Fundus photo
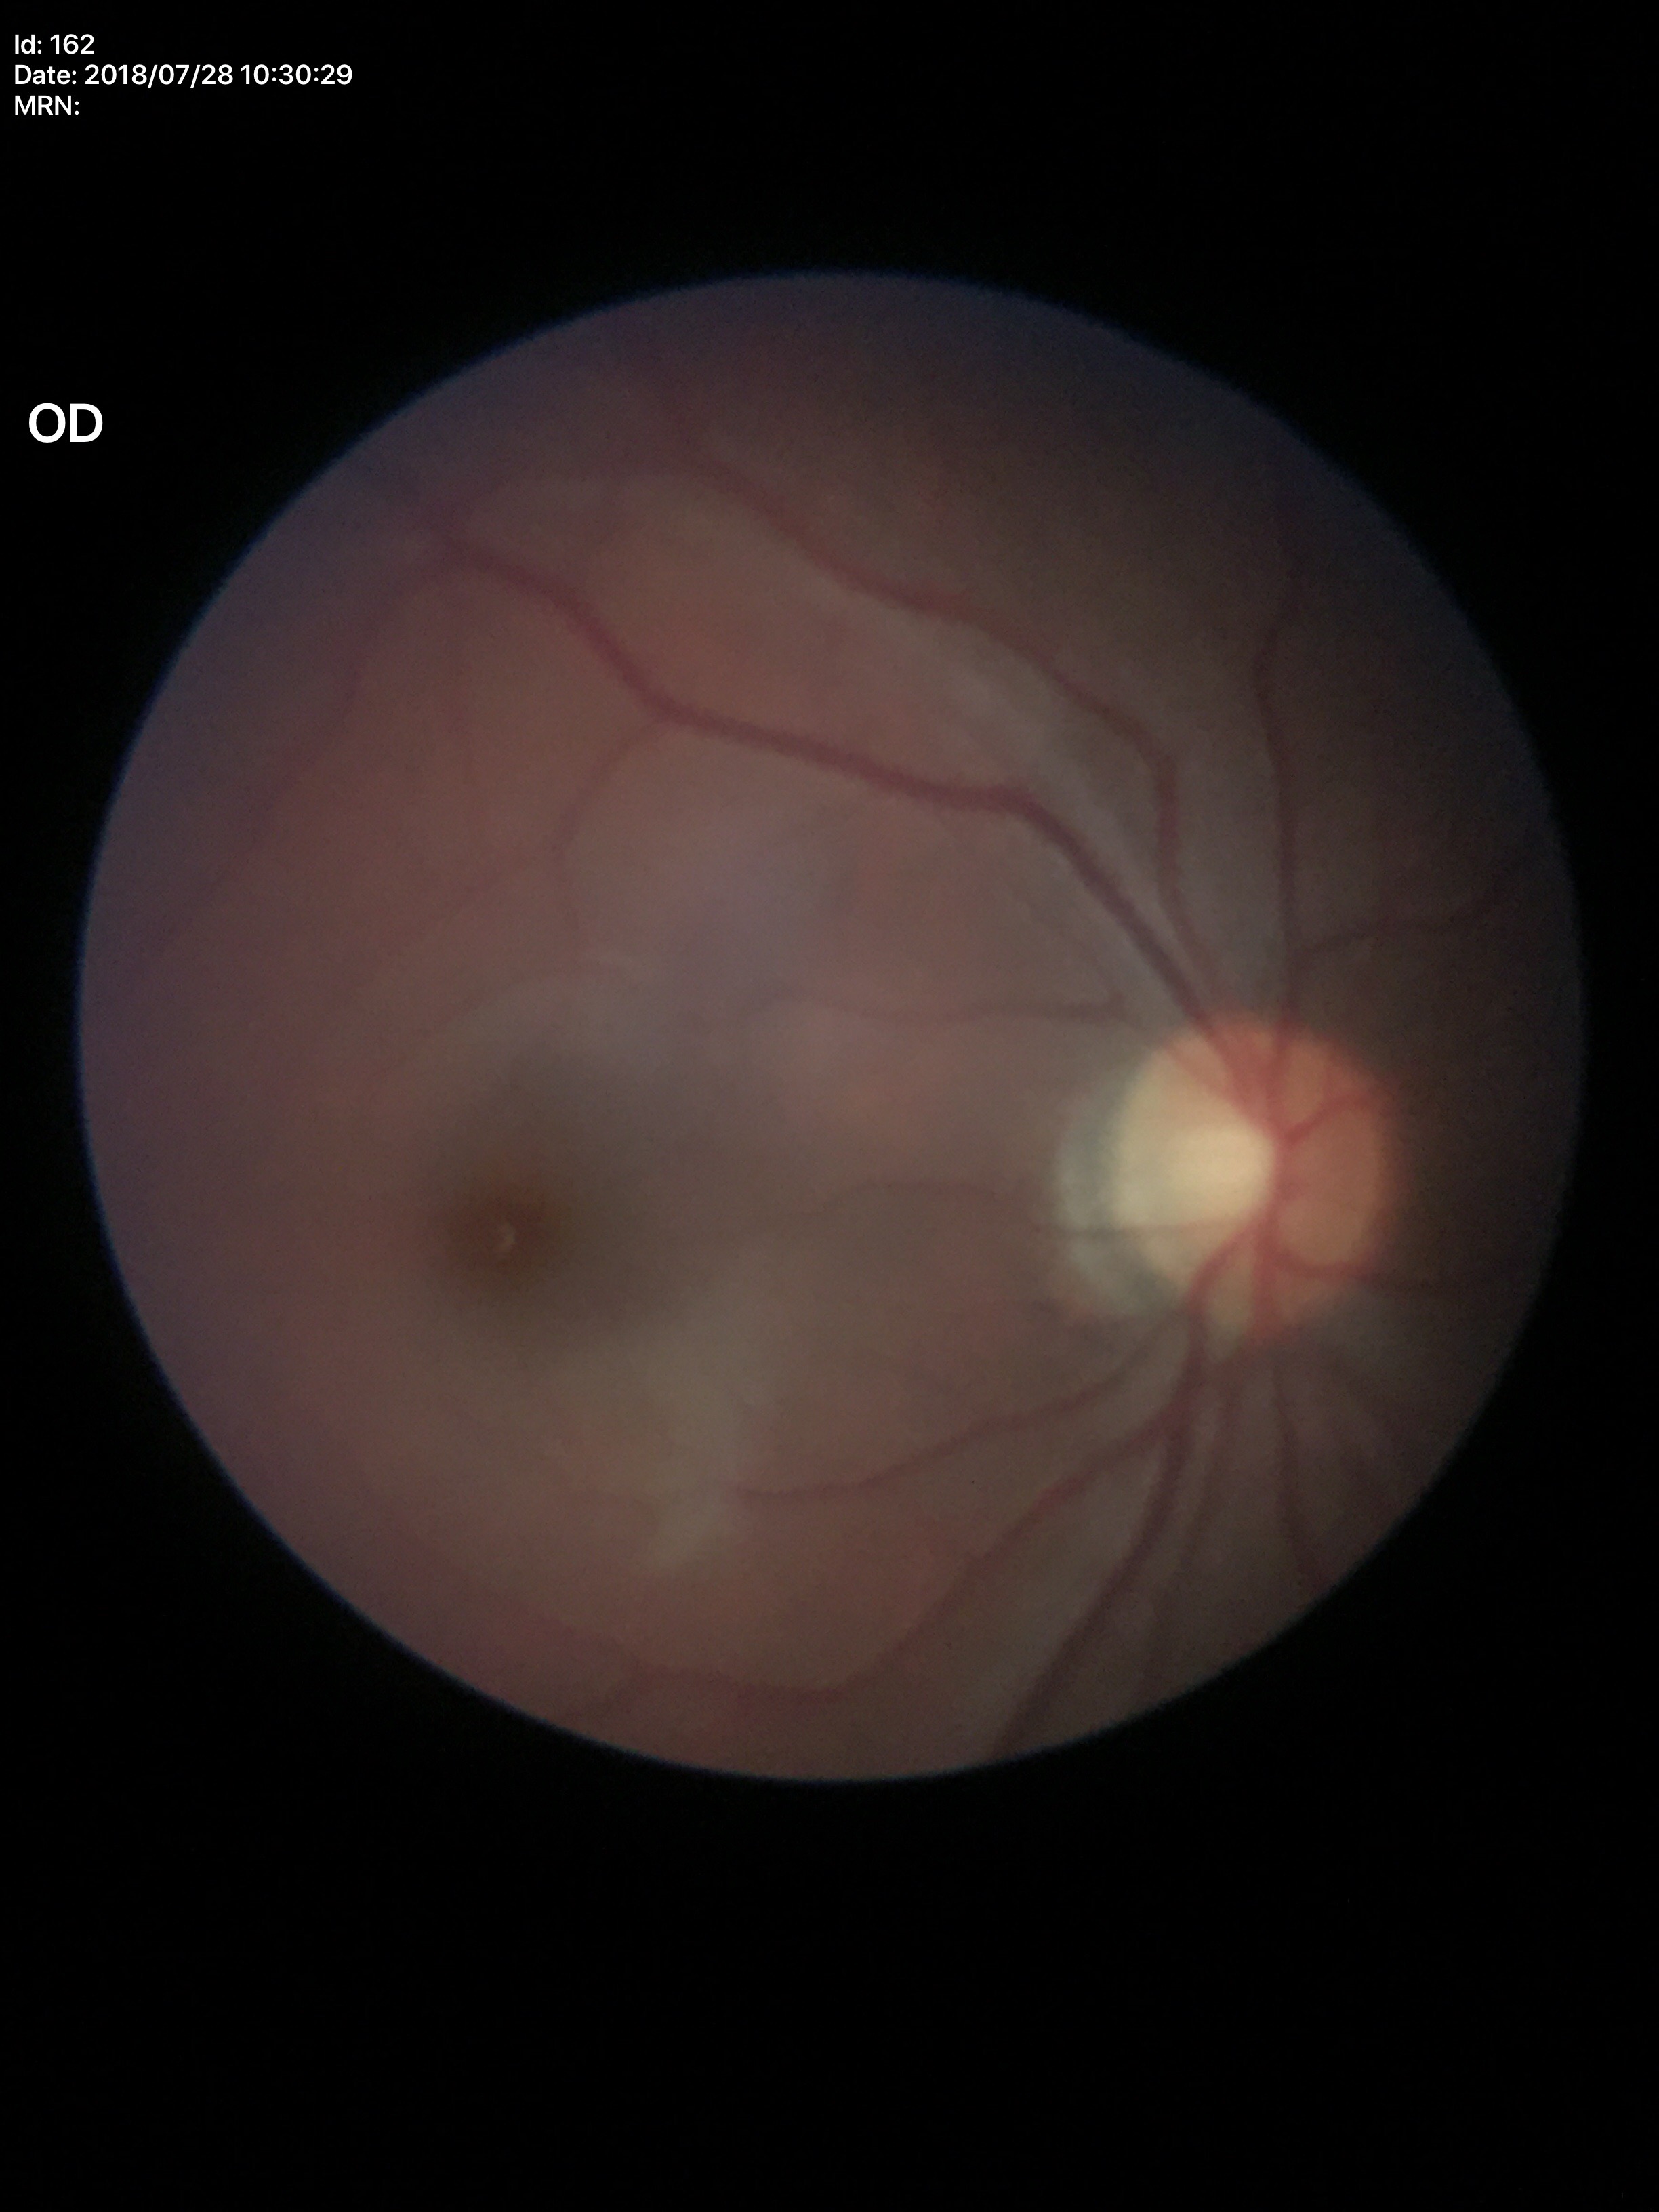

Glaucoma decision: negative (1/5 graders called glaucoma suspect).
VCDR is 0.52.
ACDR is 0.26.